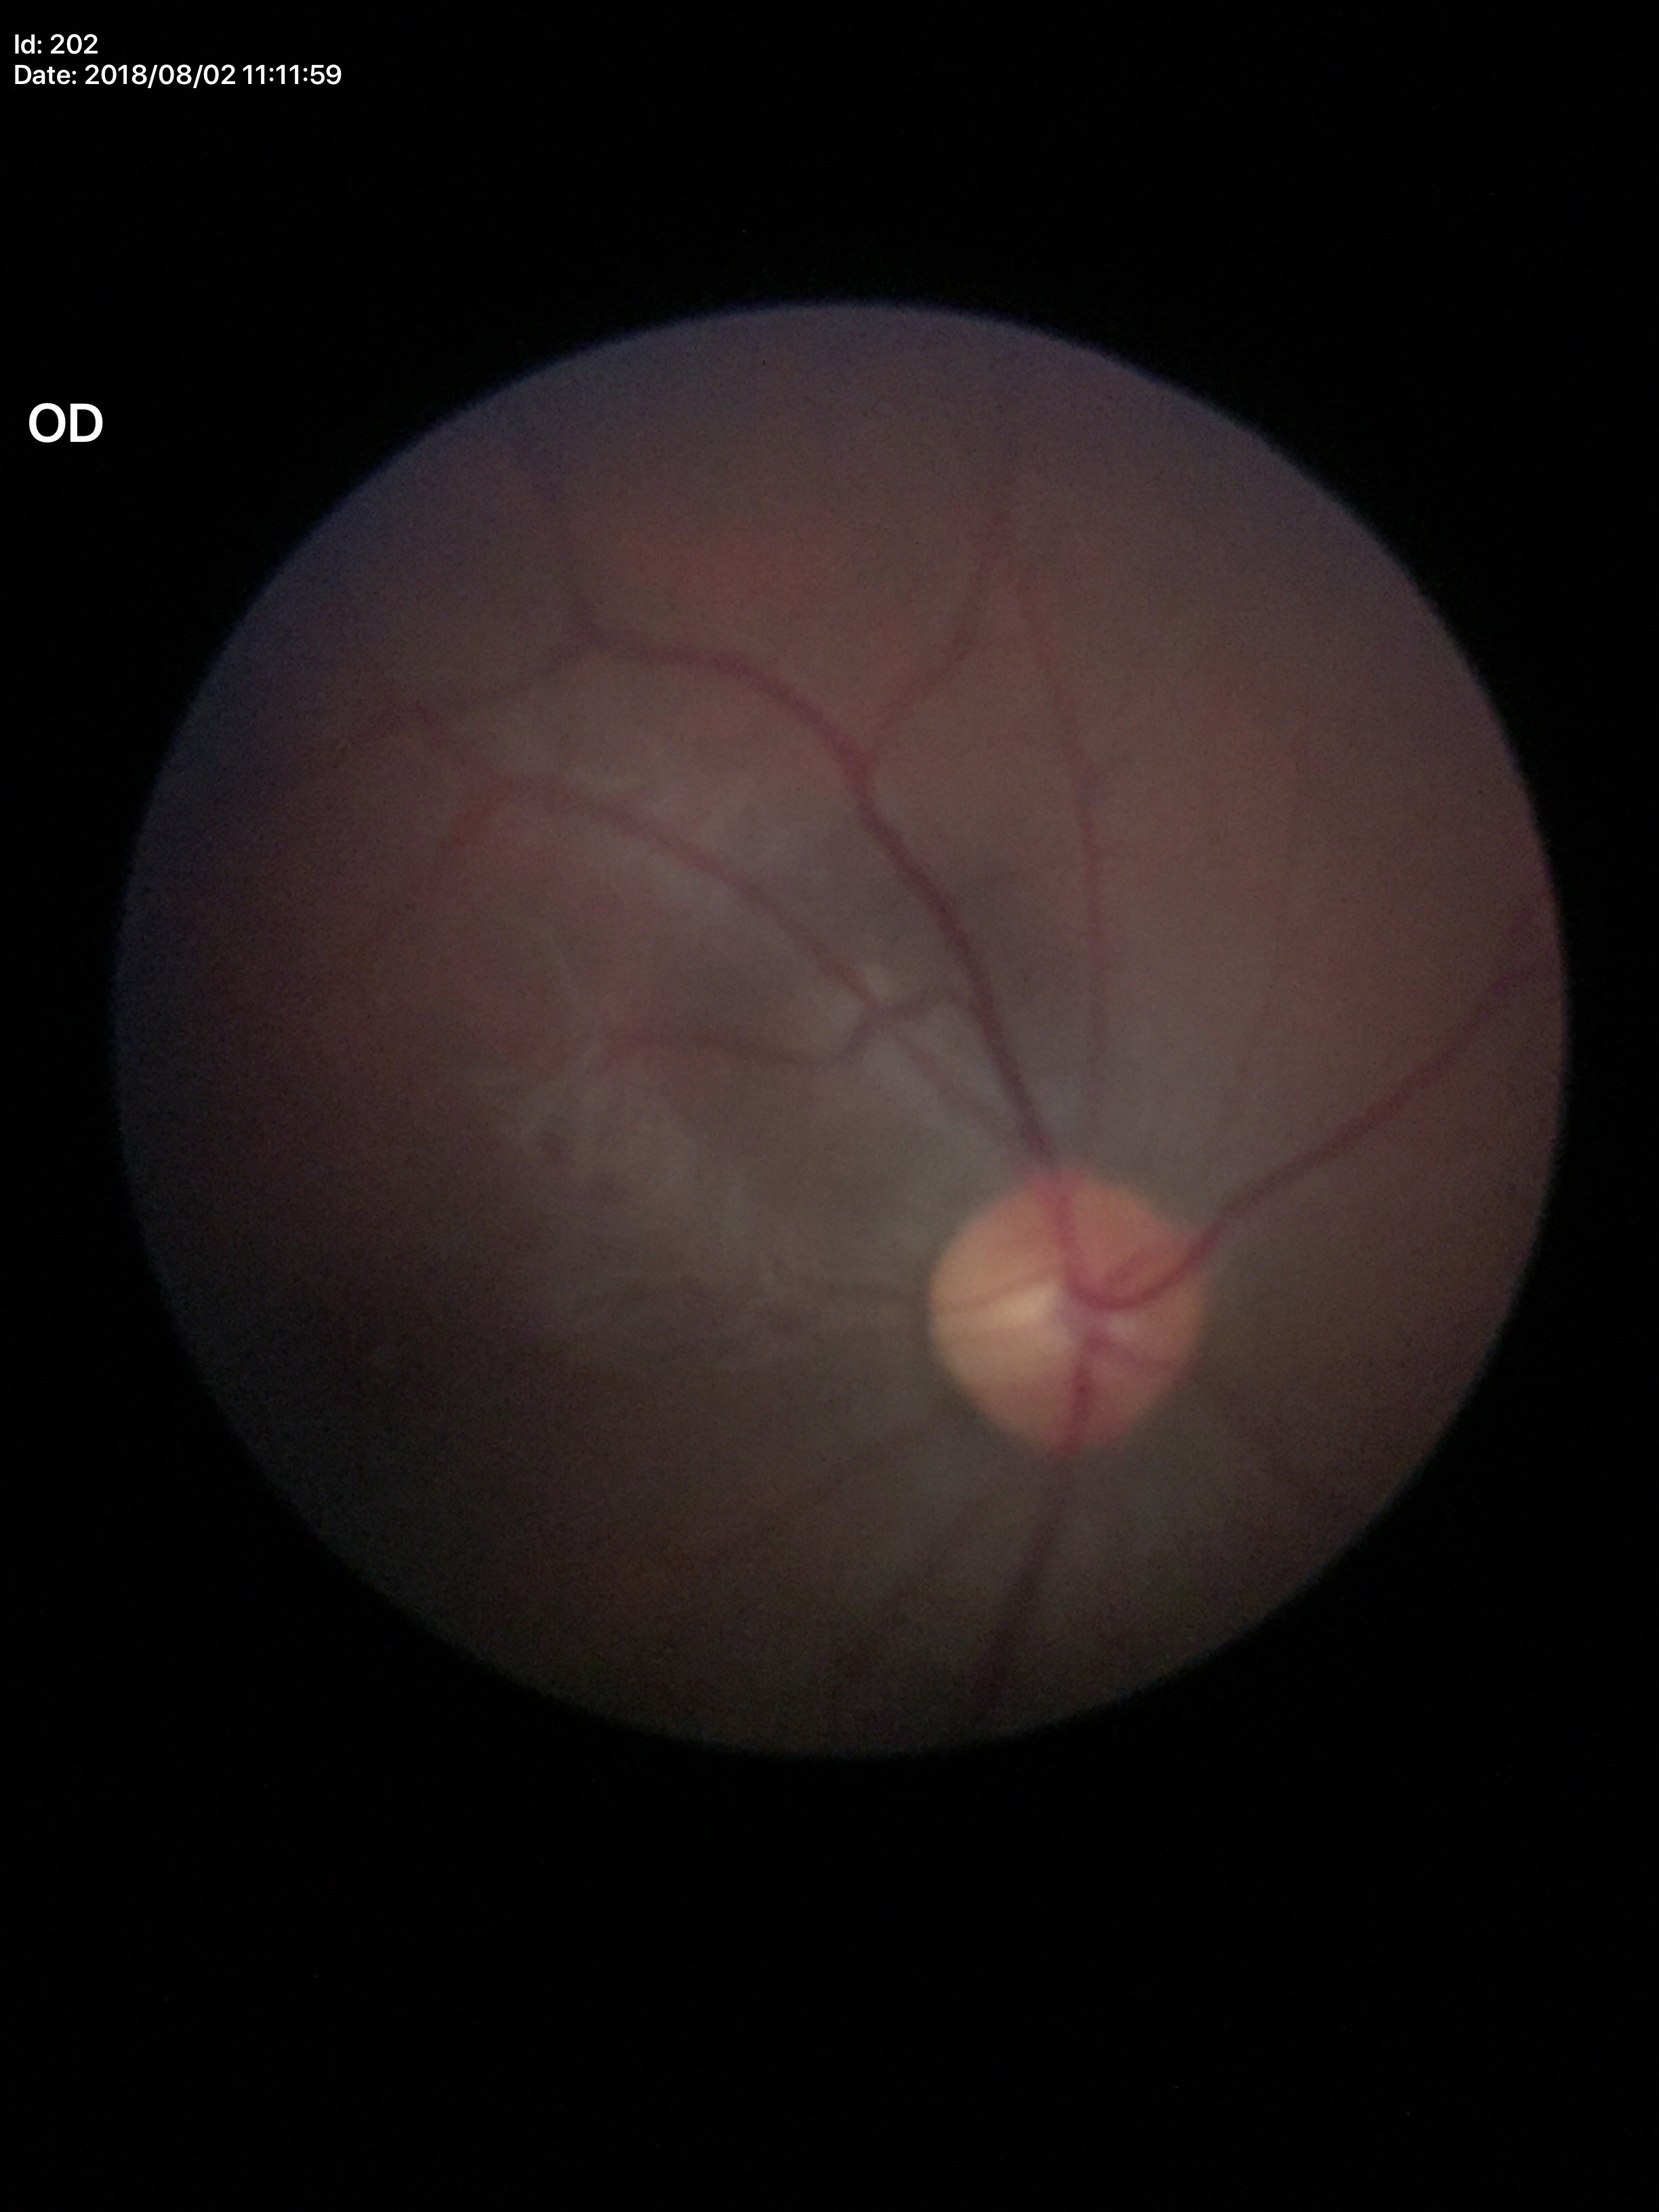 Glaucoma screening: negative. Vertical cup-disc ratio is 0.48.